2352 by 1568 pixels: 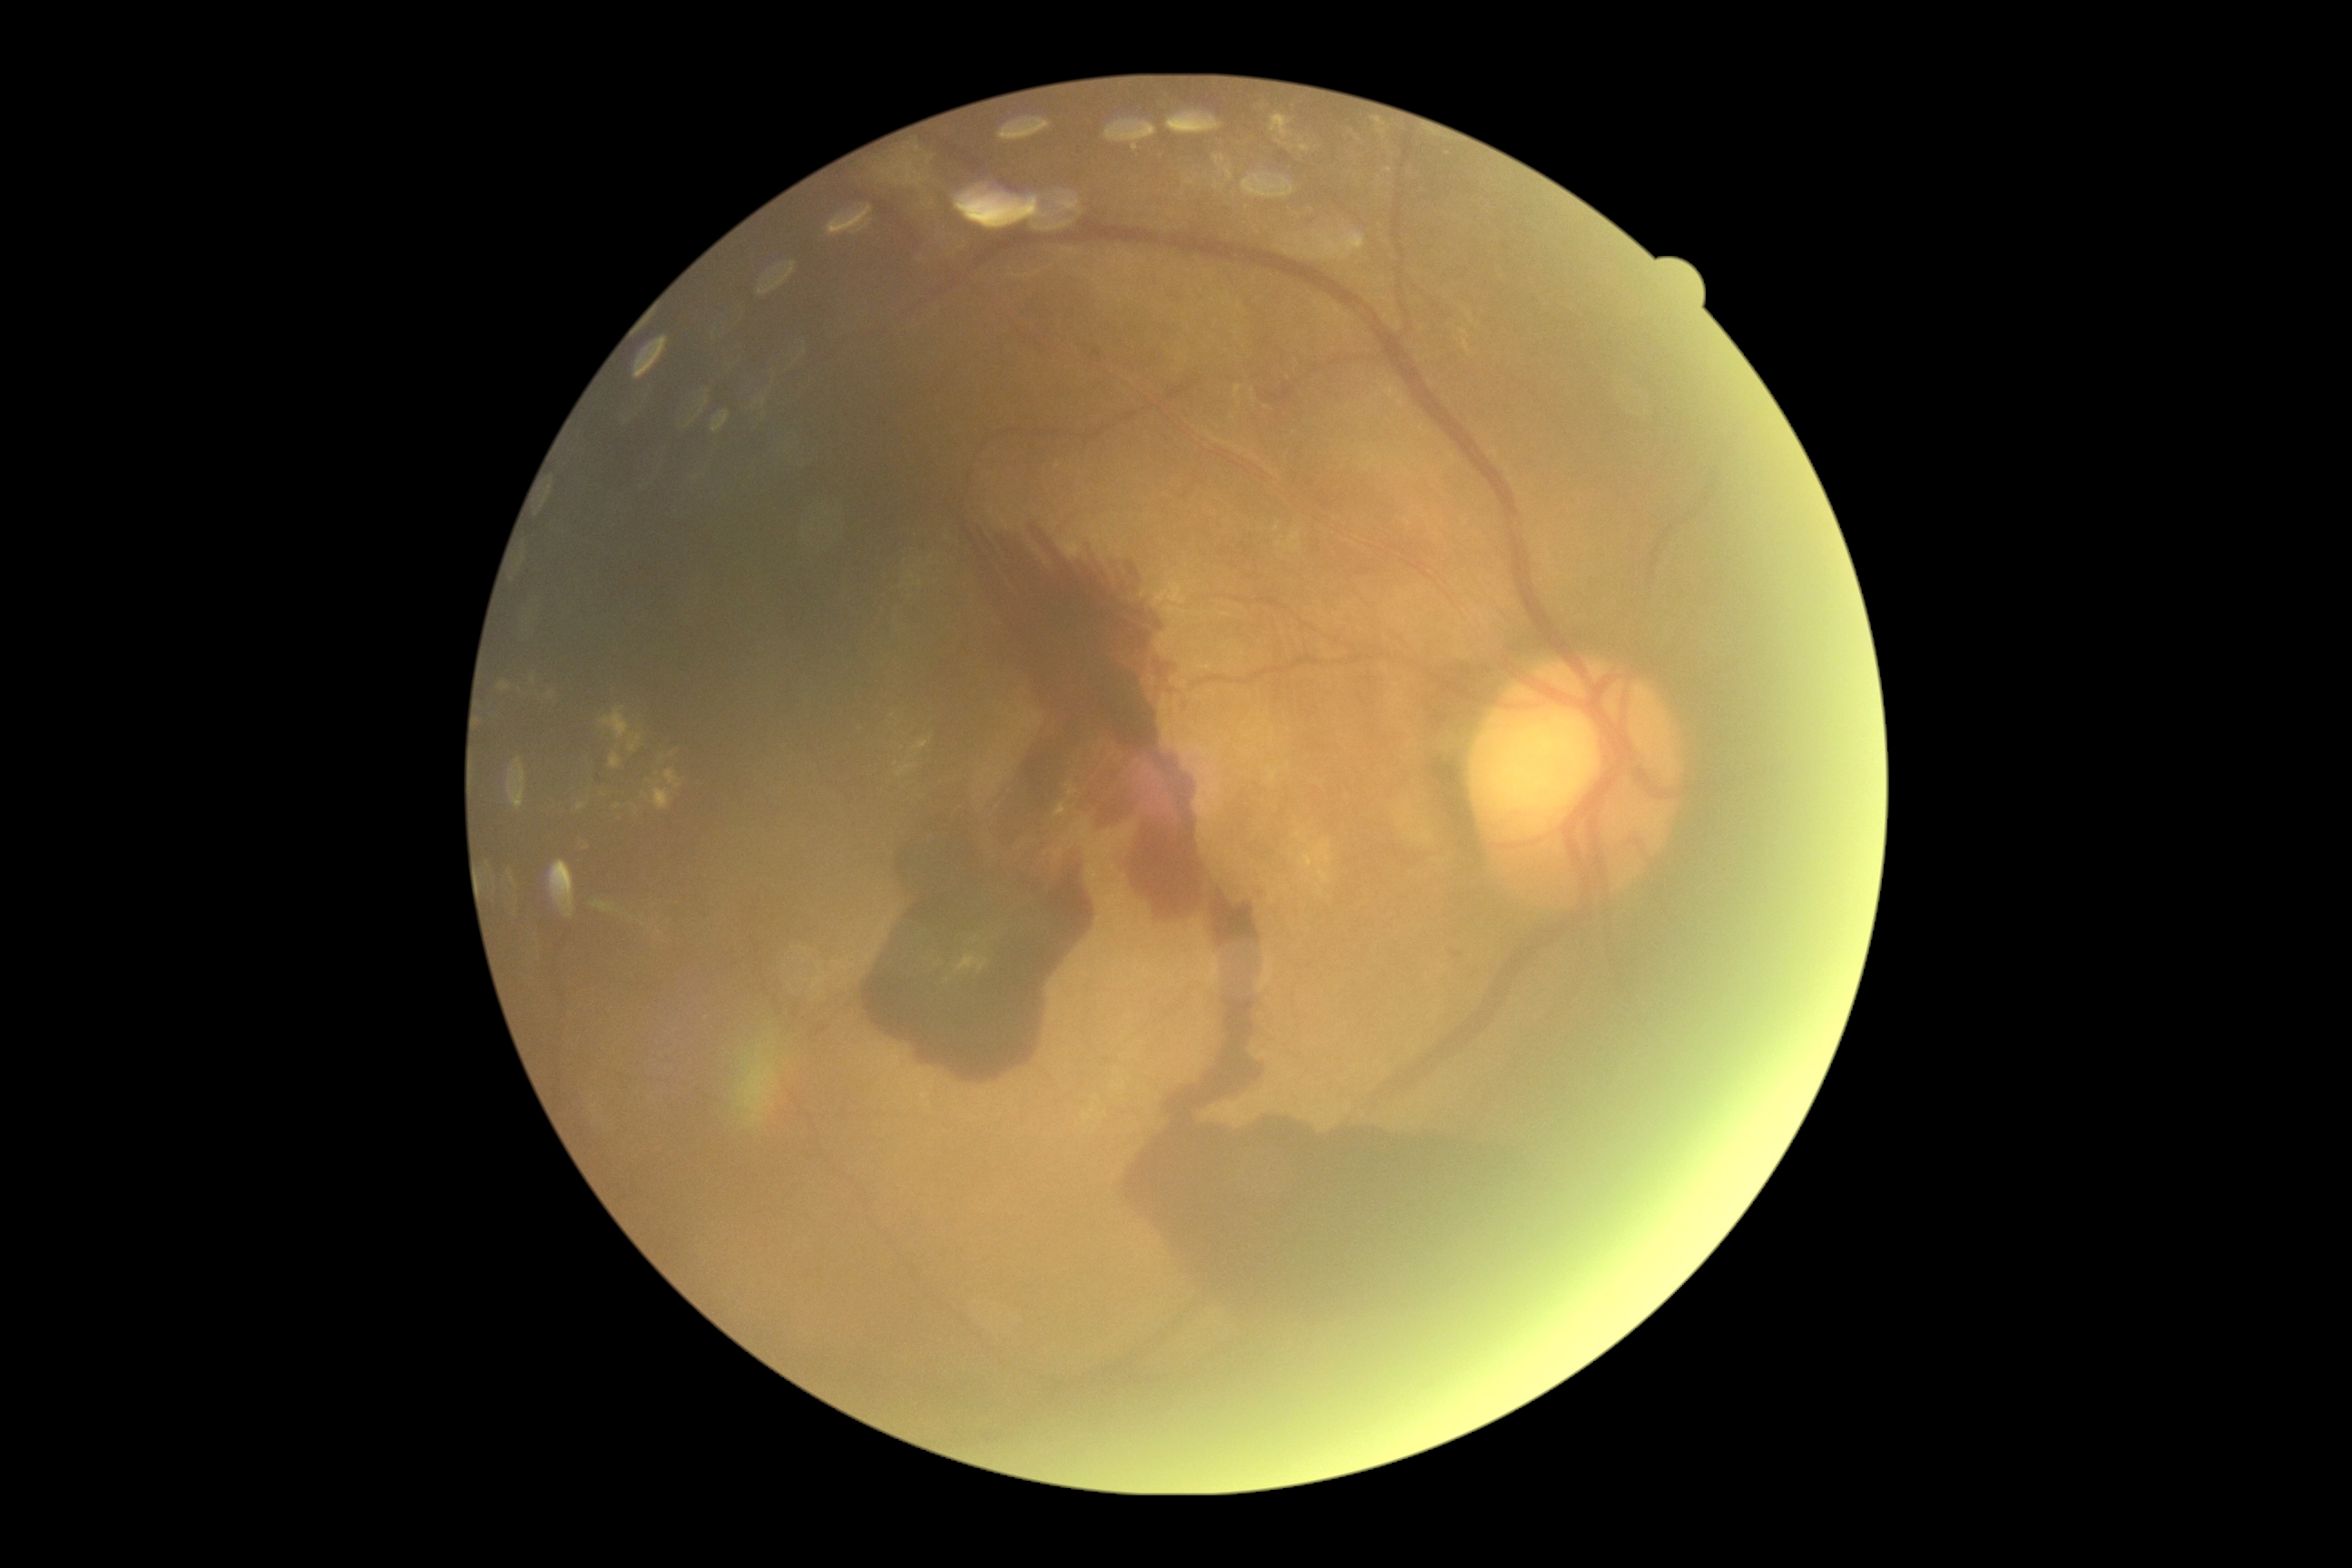

* DR severity: 4/4